Camera: Topcon TRC-NW400; disc-centered field; pachymetry 540 µm; color fundus image
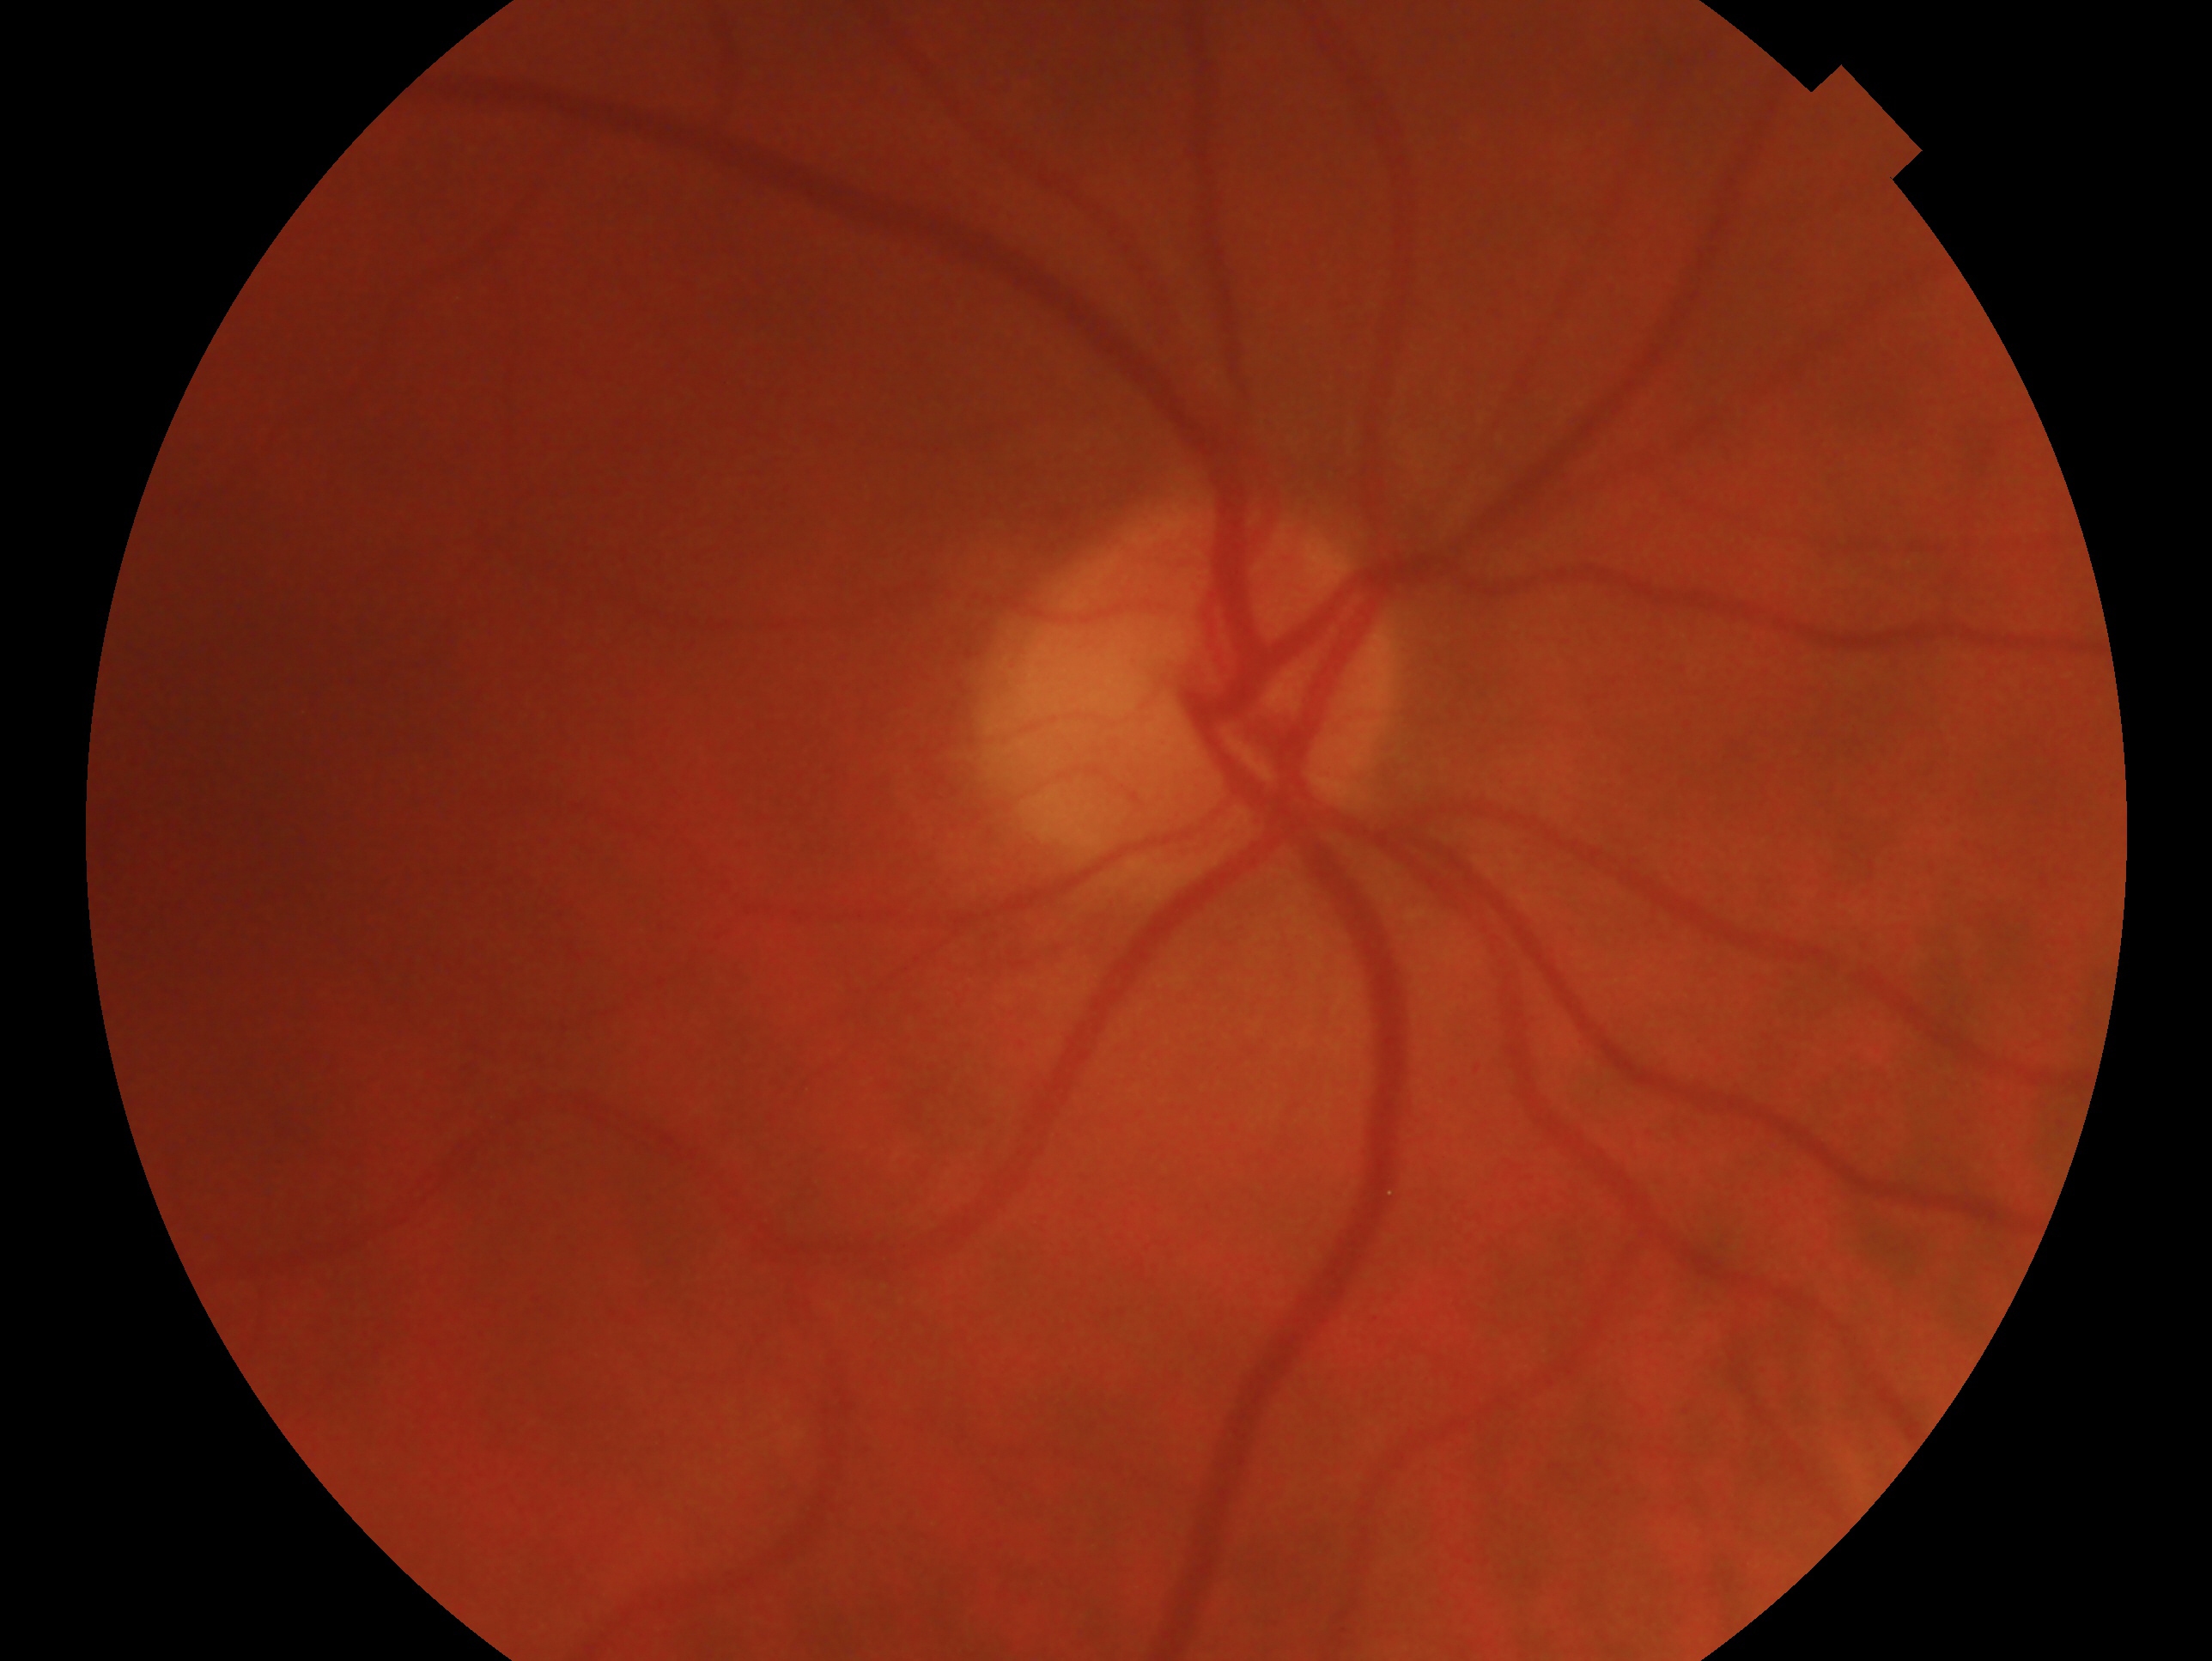

Q: What is the glaucoma diagnosis?
A: no signs of glaucoma
Q: Right or left eye?
A: oculus dexter